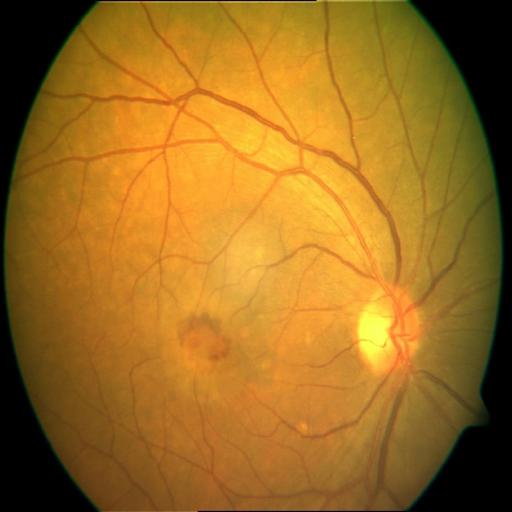 Impression:
- chorioretinitis